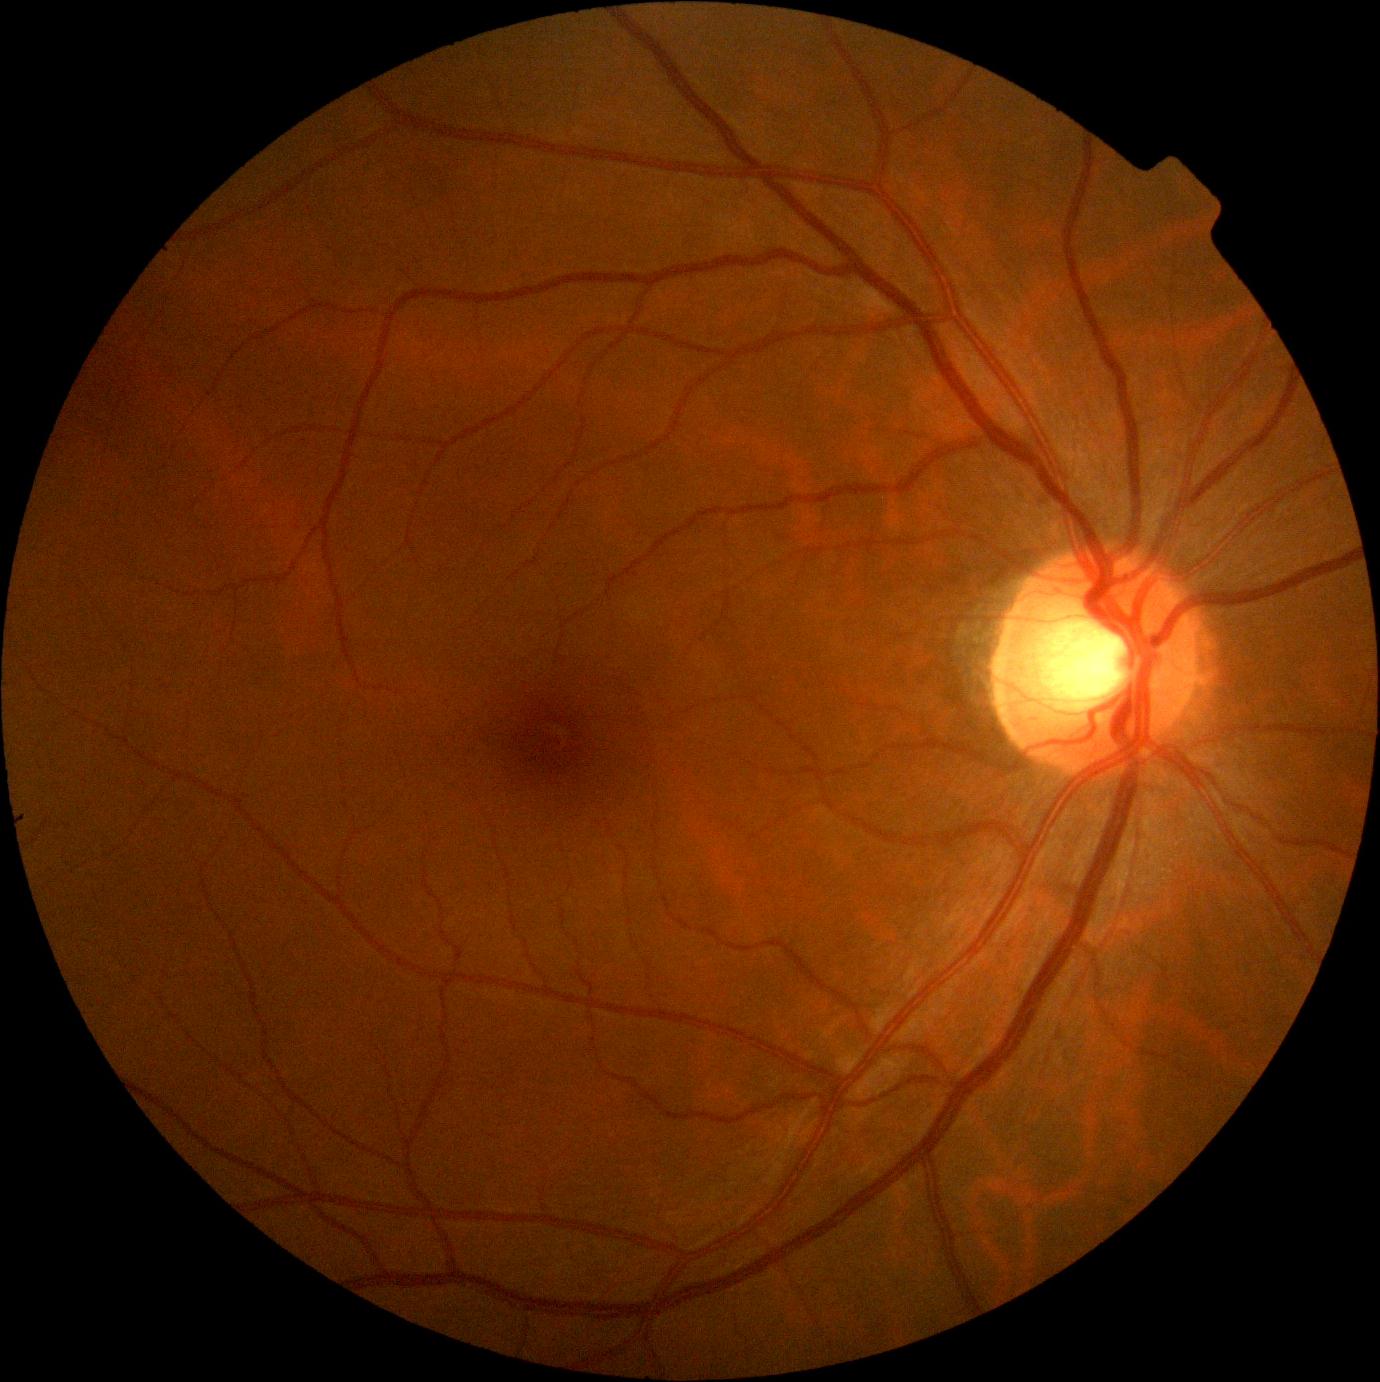

No apparent diabetic retinopathy. Retinopathy is grade 0.